Captured with the Phoenix ICON (100° field of view) · wide-field fundus photograph of an infant · 1240 x 1240 pixels: 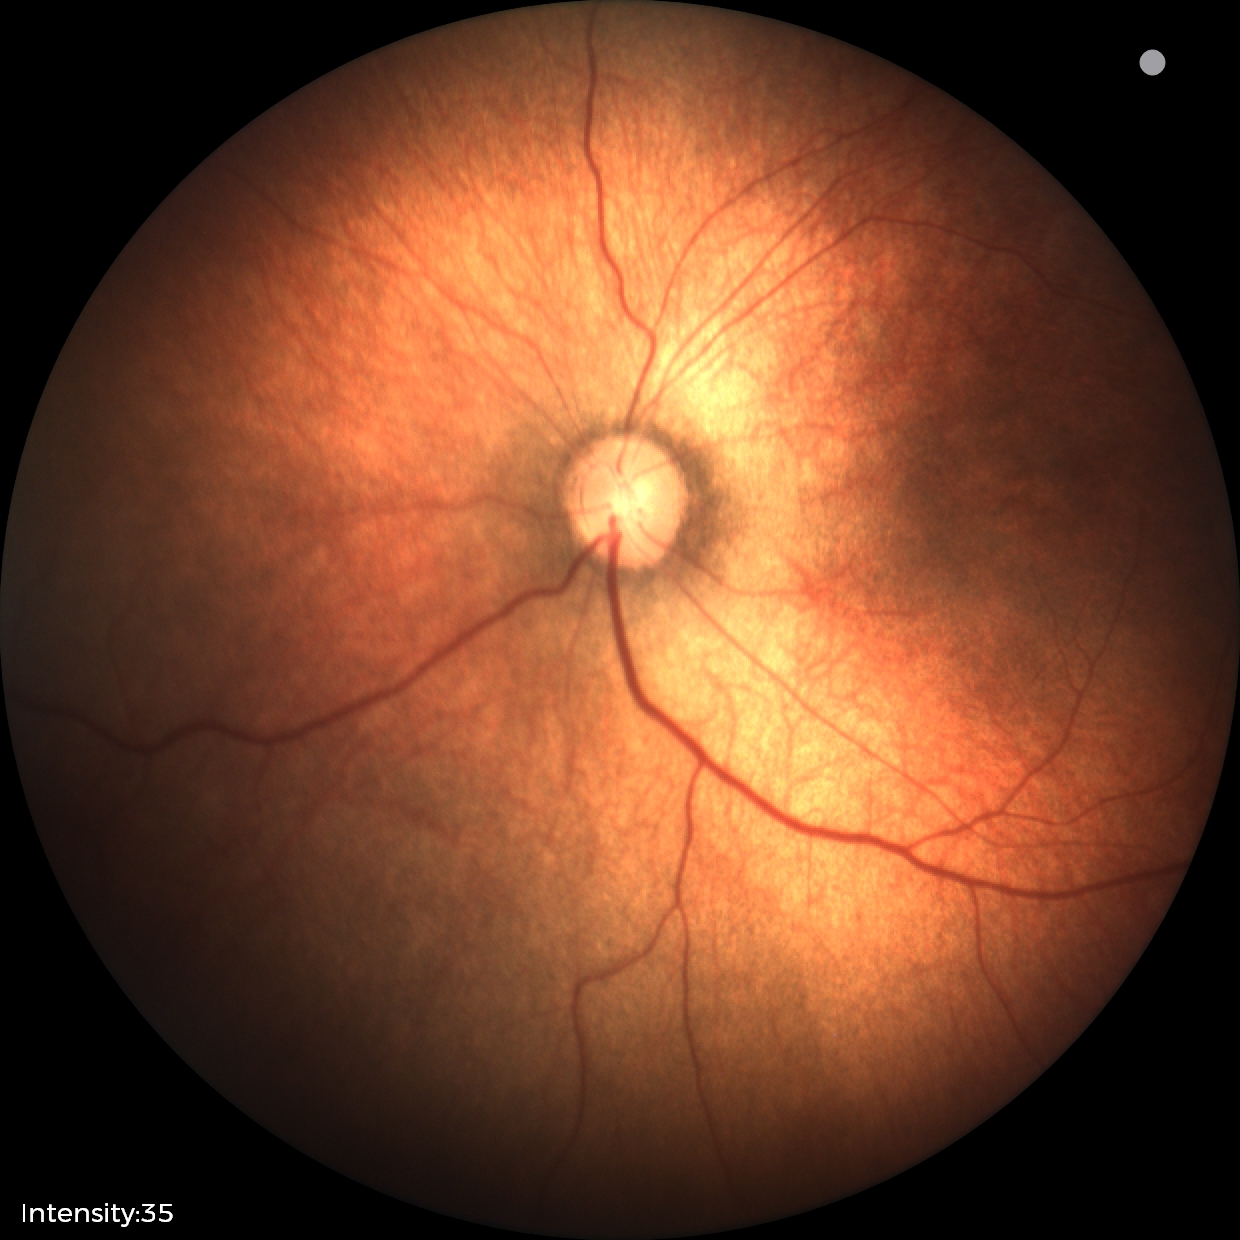 No retinal pathology identified on screening.